Non-mydriatic — 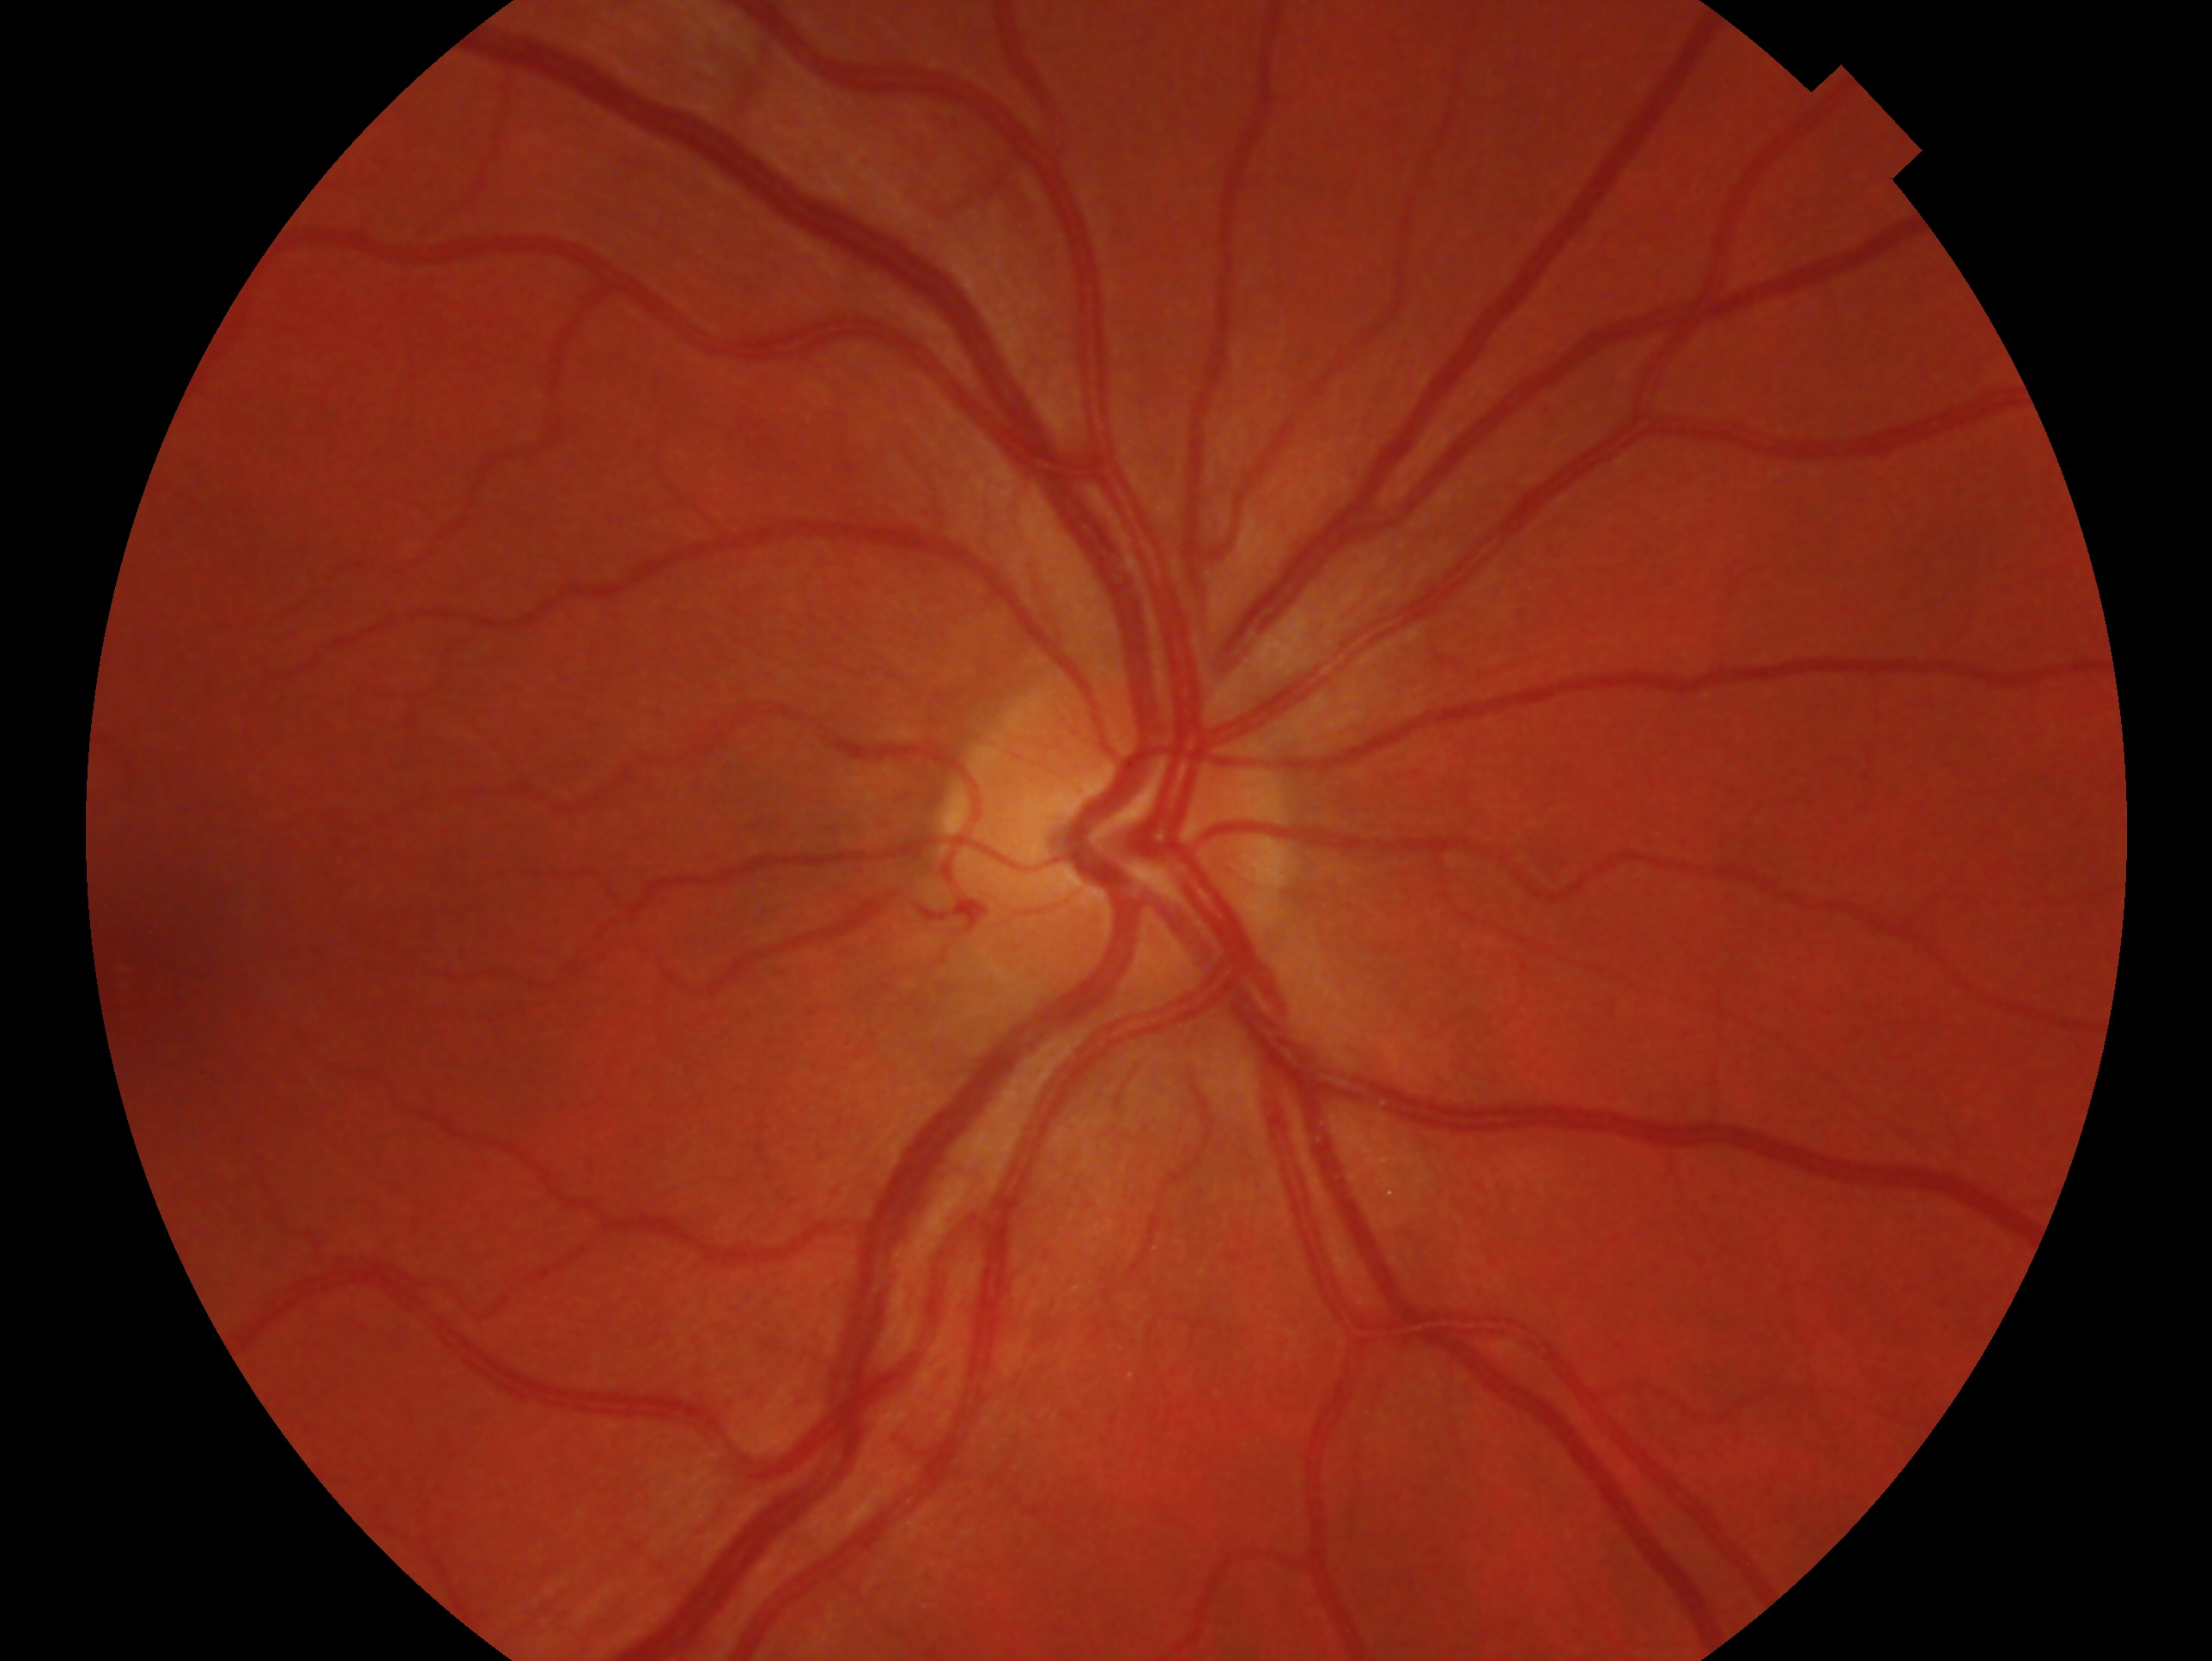
Diagnosis: no evidence of glaucoma.
Eye: OD.